45-year-old patient. Captured on a Topcon TRC-NW400 fundus camera. 30° field of view.
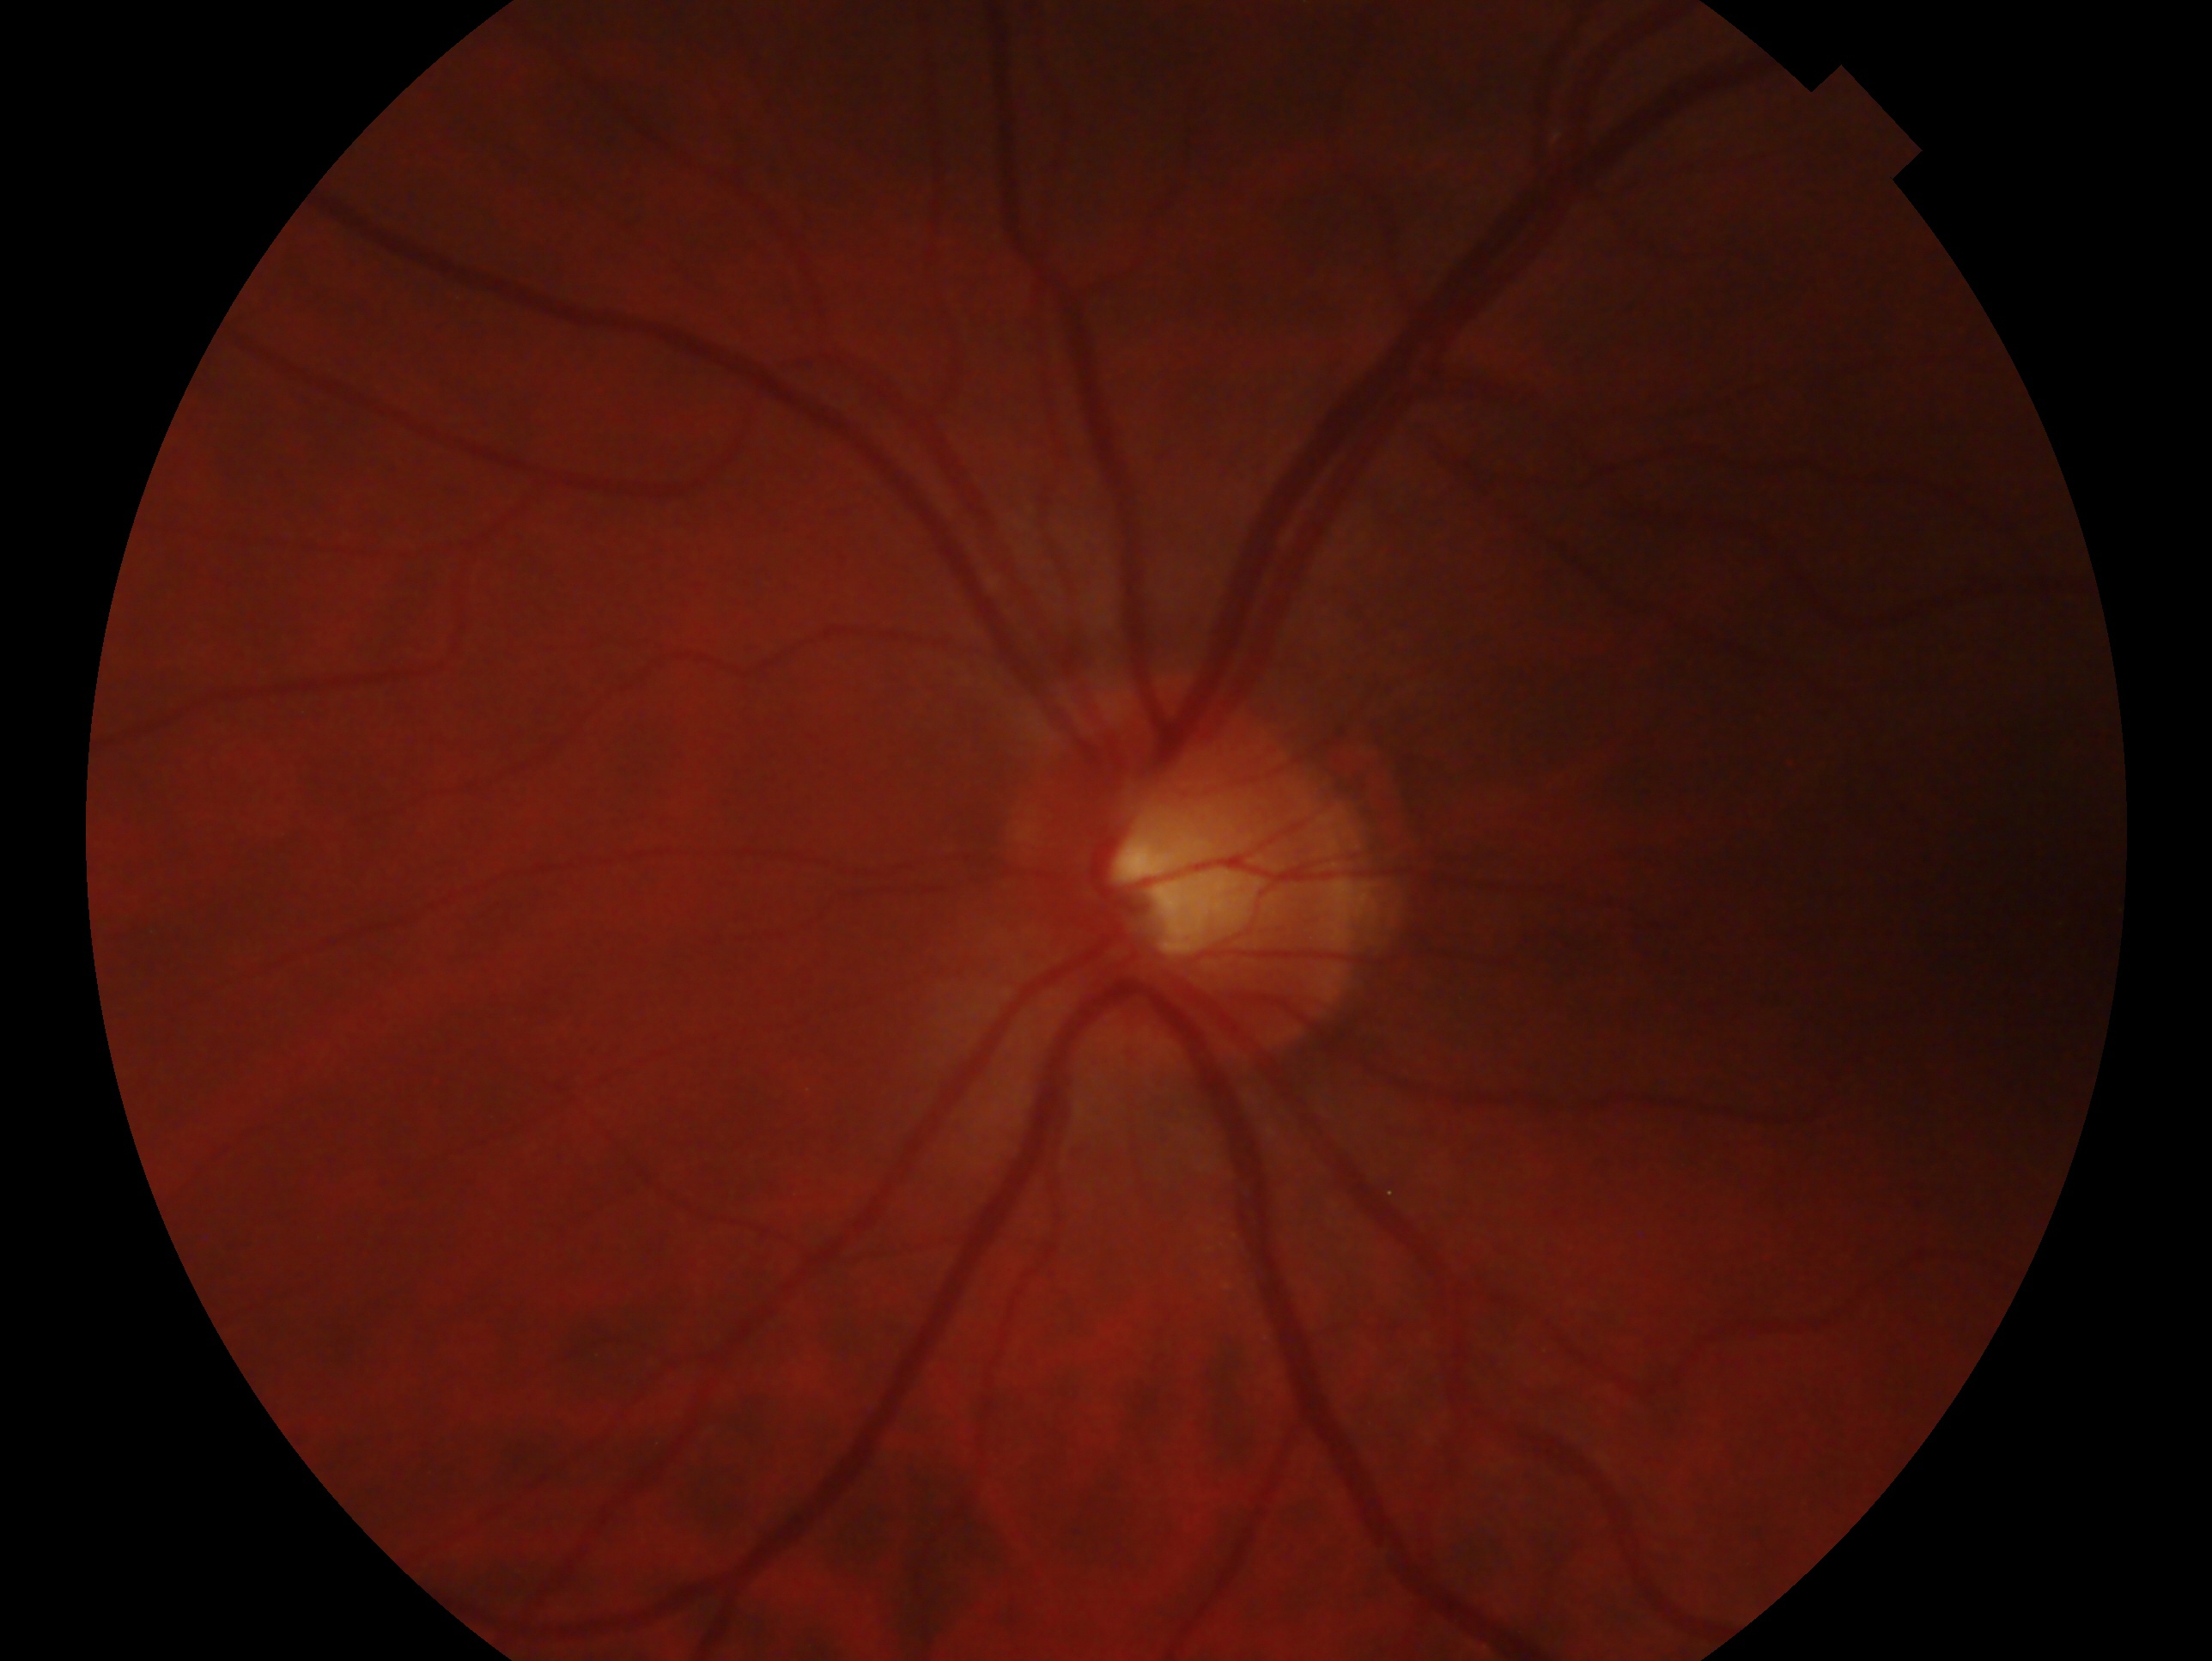
Glaucoma assessment: no glaucomatous findings — no clinical evidence of glaucoma in this eye. The image shows the left eye.